2048 by 1536 pixels. 45° field of view.
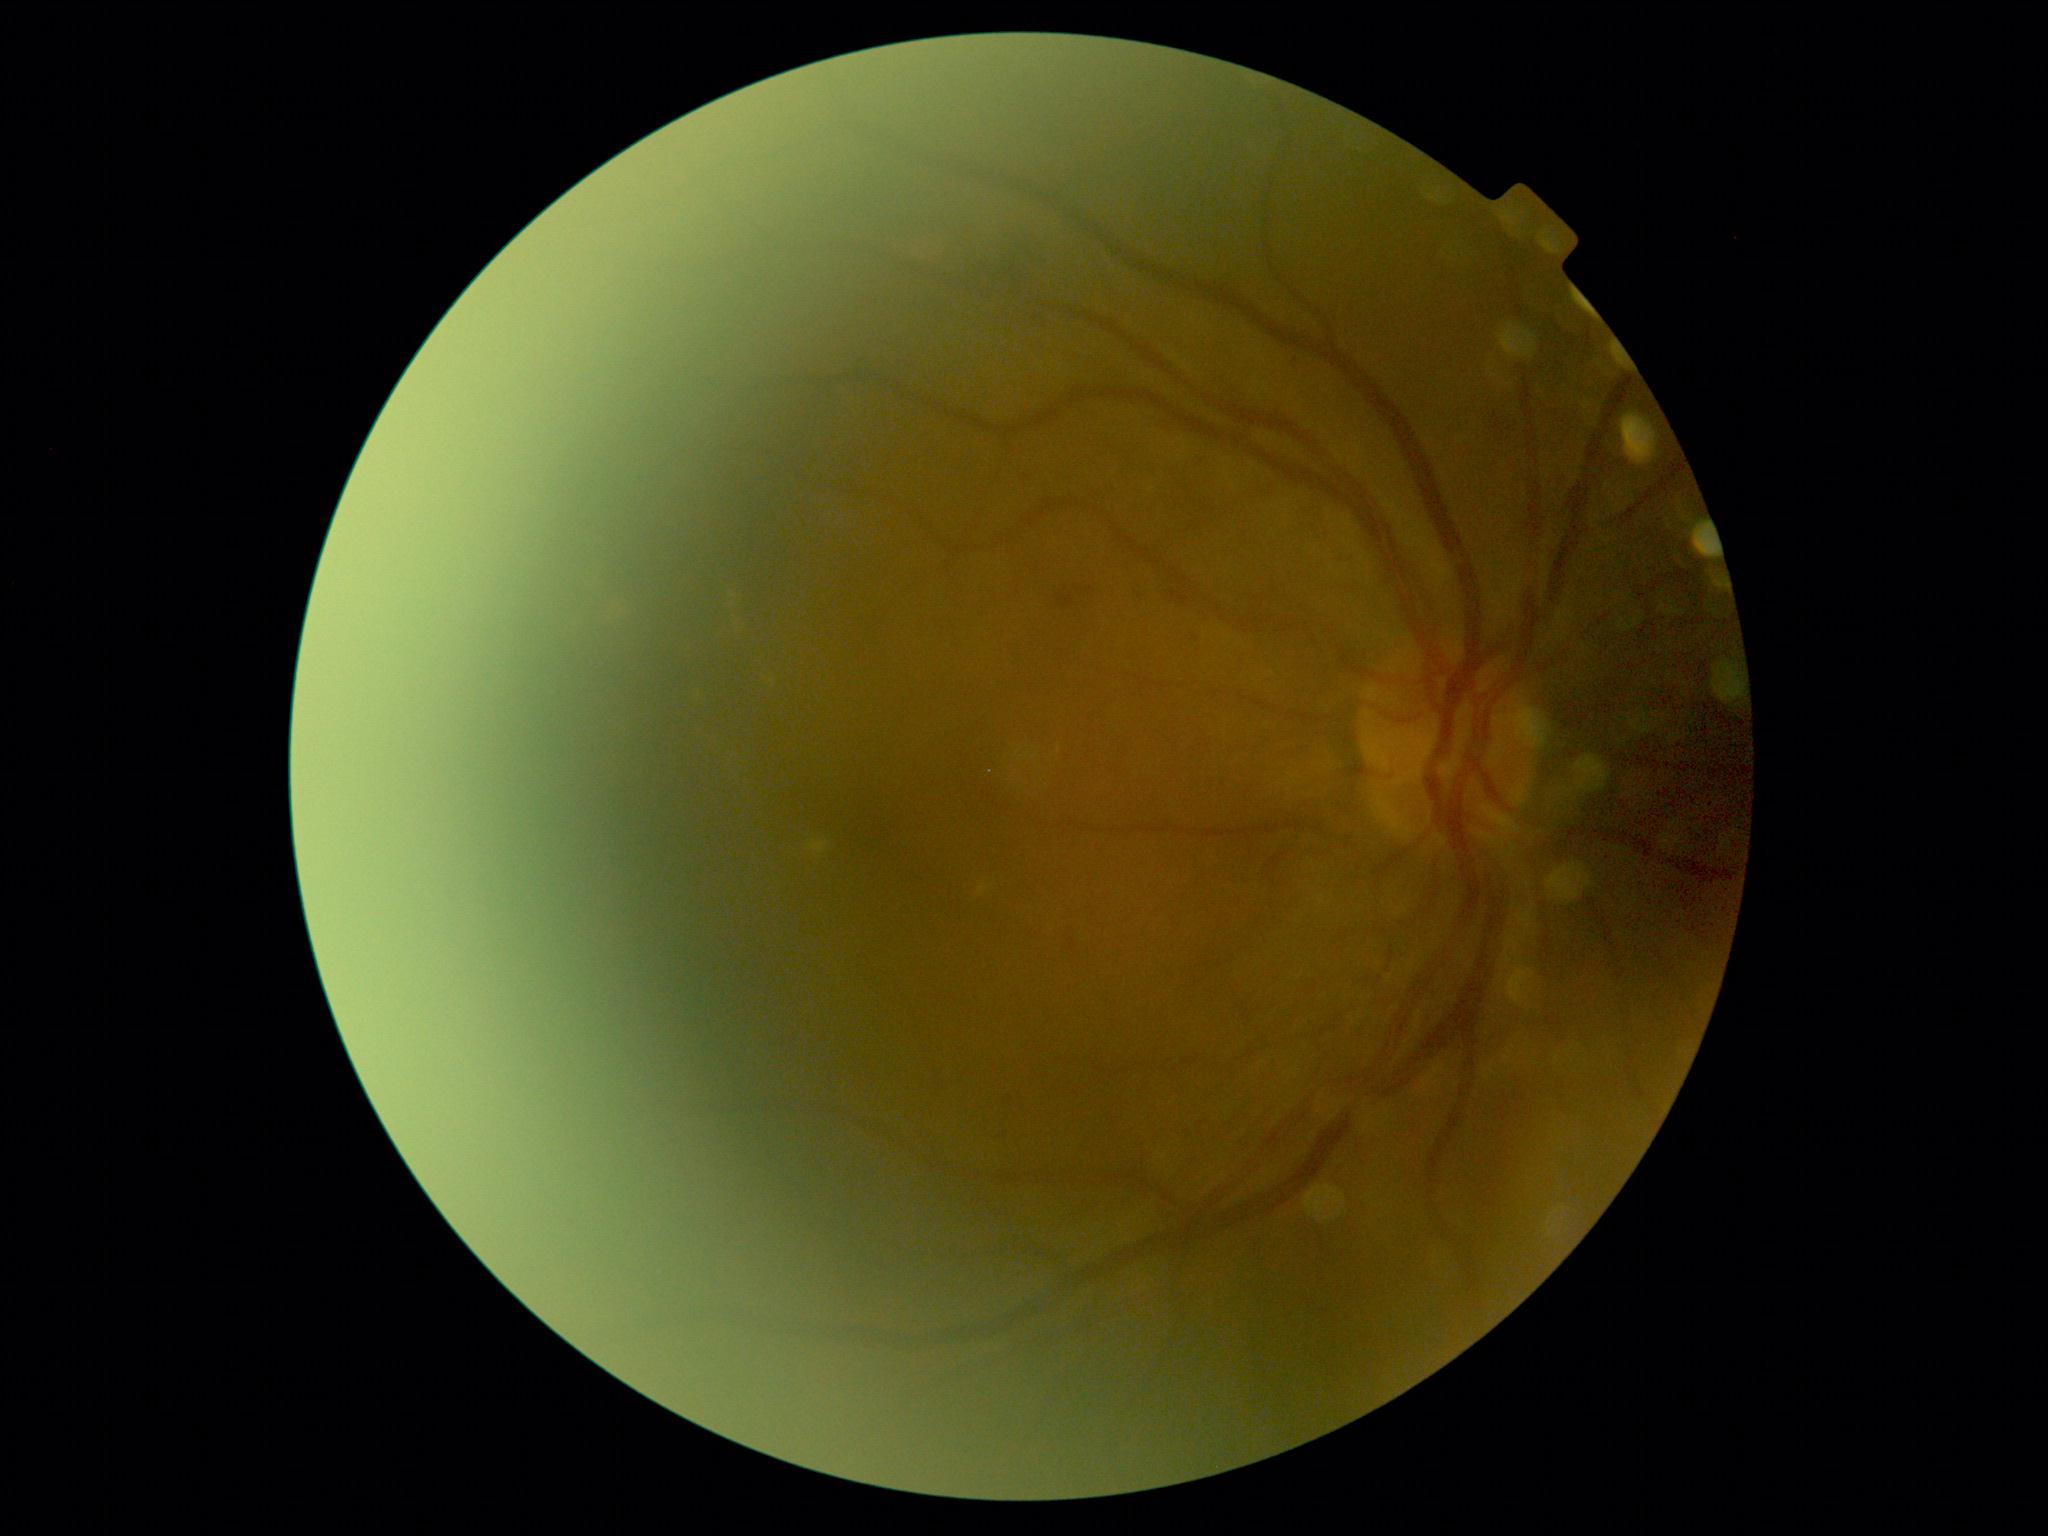 DR stage is 2.